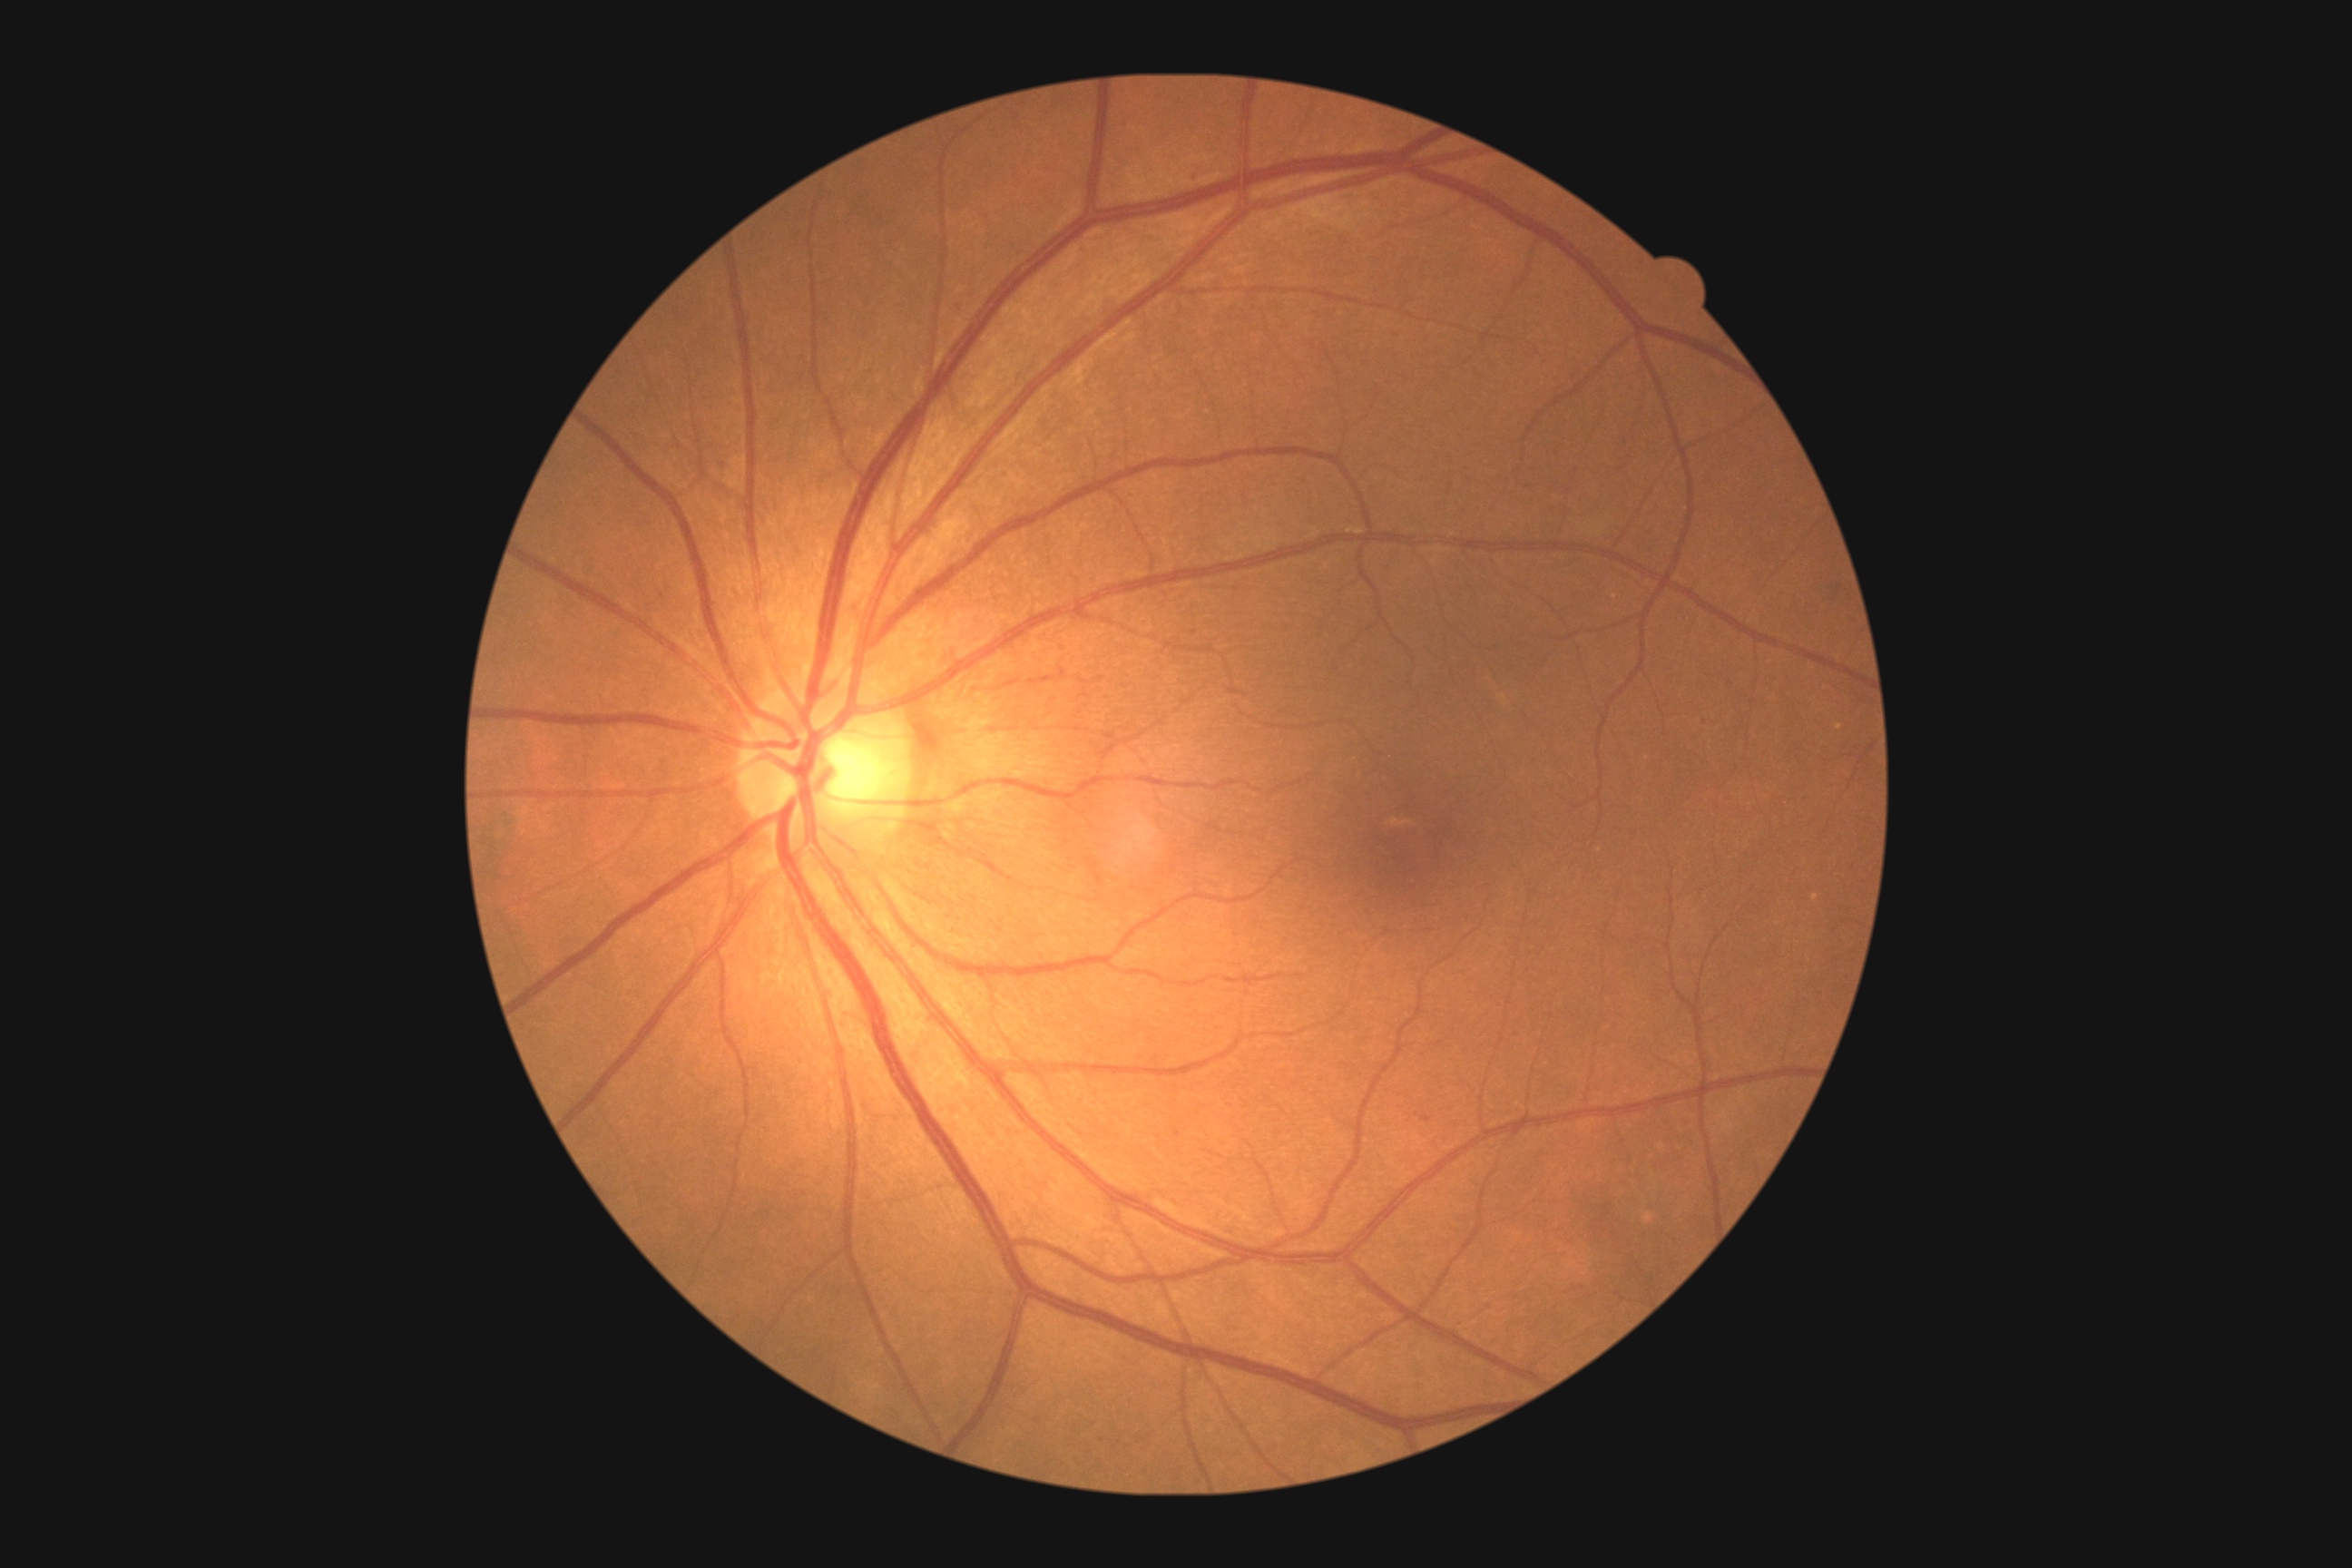 diabetic retinopathy severity = grade 1 (mild NPDR), DR class = non-proliferative diabetic retinopathy.